Image size 1240x1240 · wide-field fundus photograph from neonatal ROP screening · acquired on the Phoenix ICON.
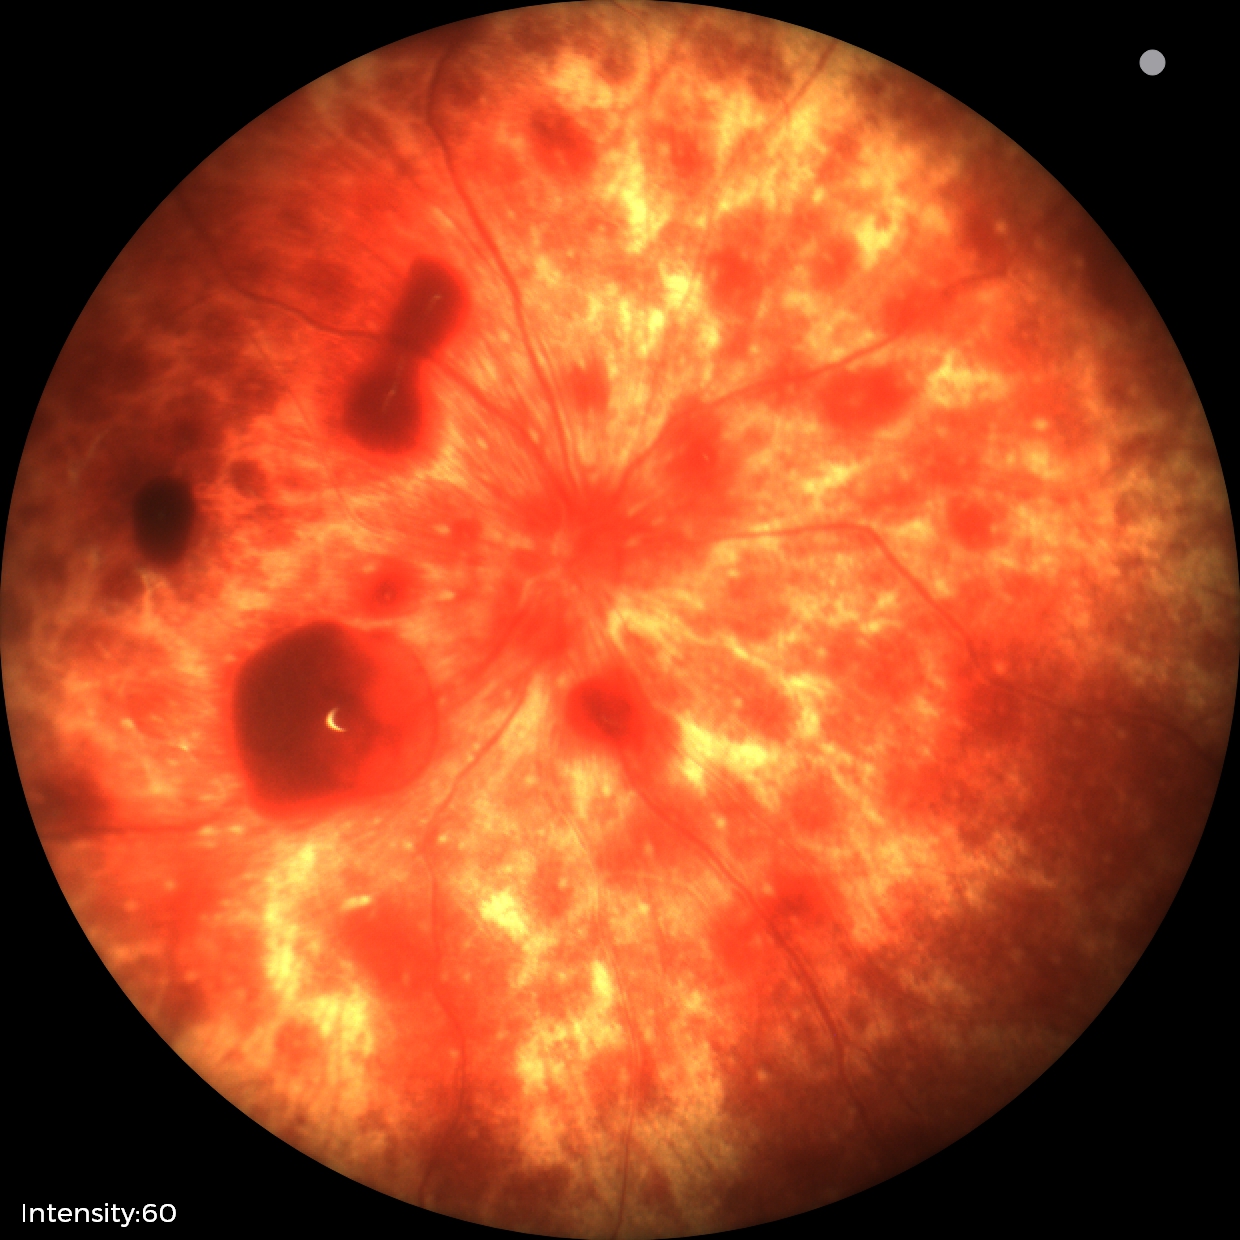 Q: What was the screening finding?
A: retinal hemorrhages